Infant wide-field retinal image; 1240 x 1240 pixels — 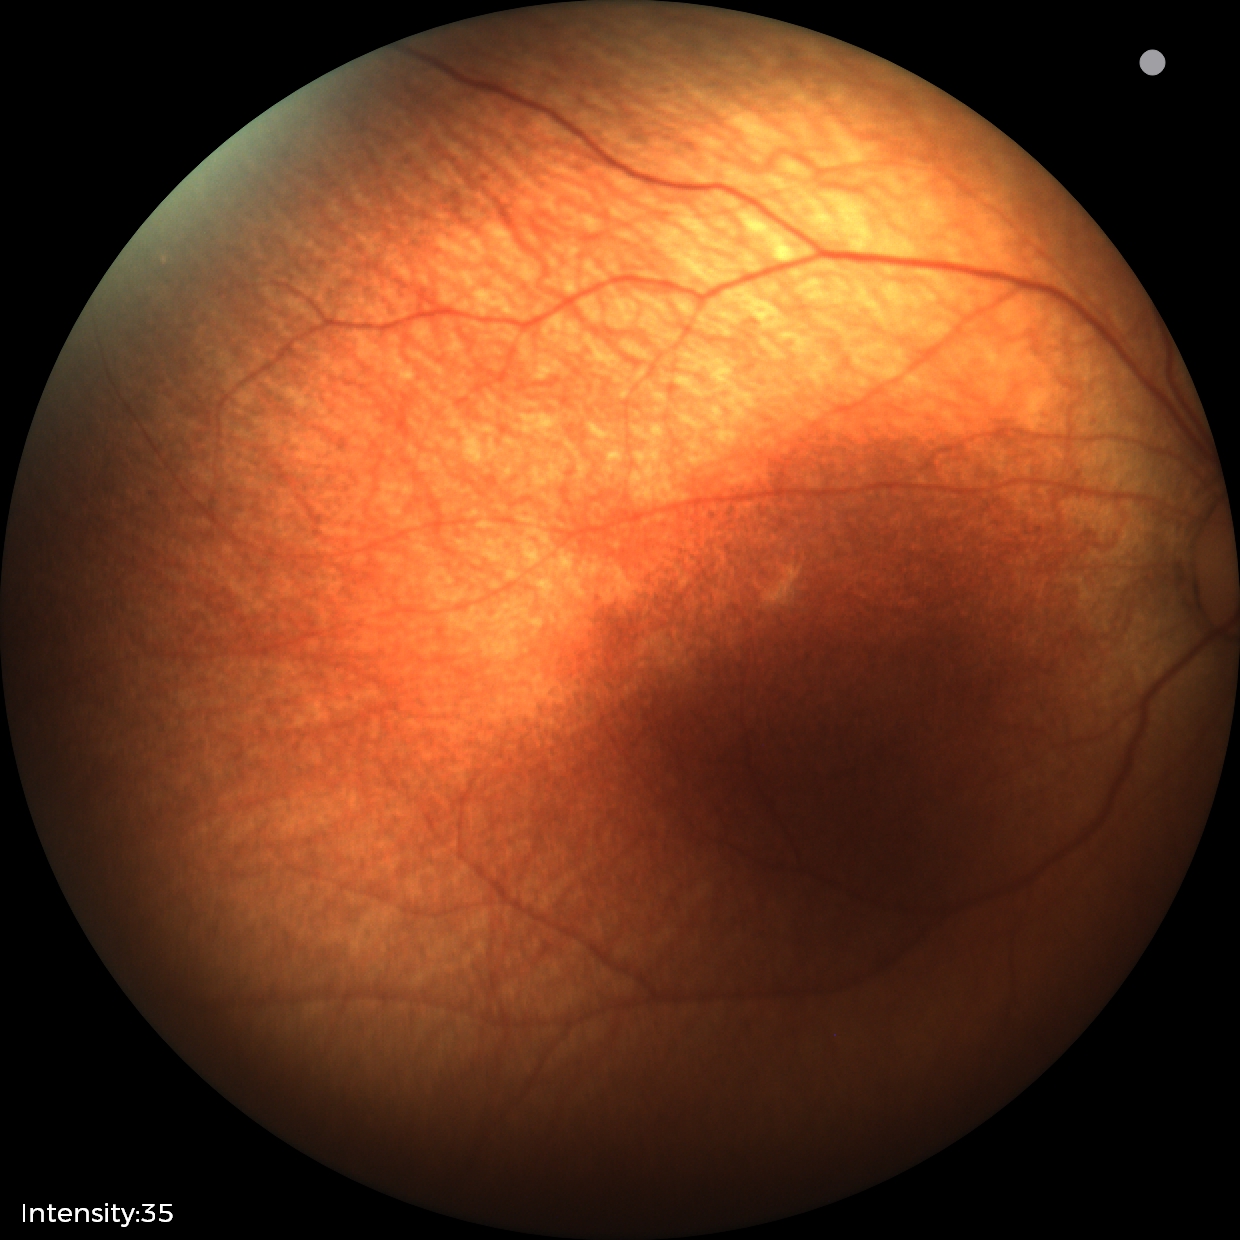
Examination with physiological retinal findings.